Infant wide-field retinal image. Natus RetCam Envision, 130° FOV. 1440x1080.
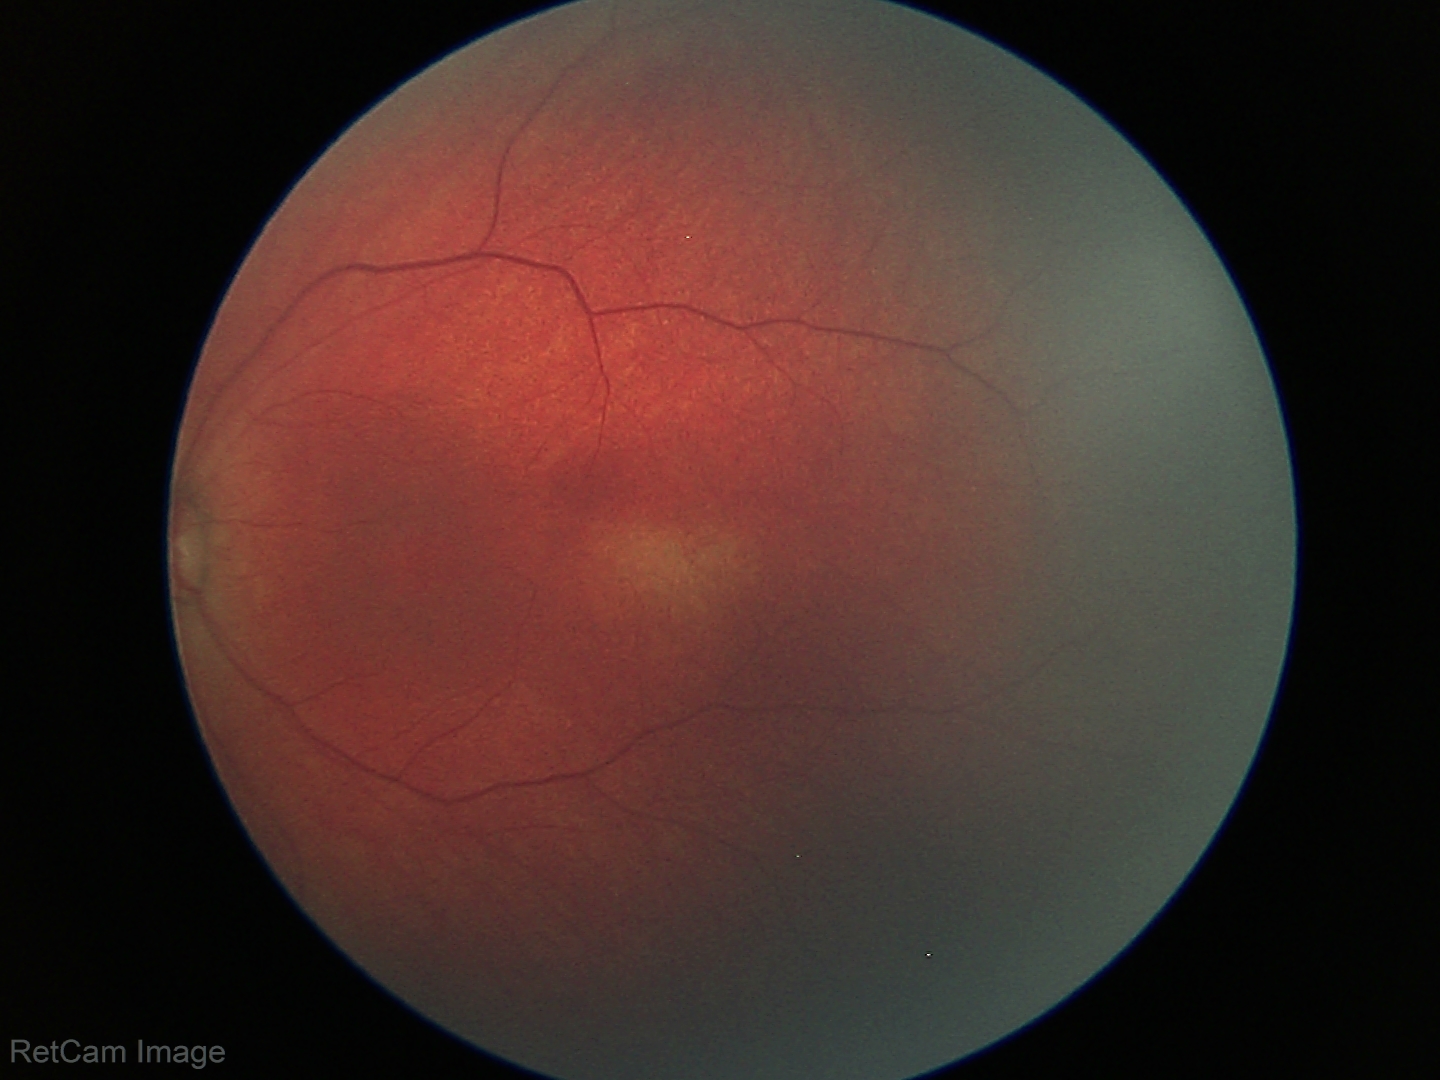 Assessment = physiological appearance.